FOV: 45 degrees.
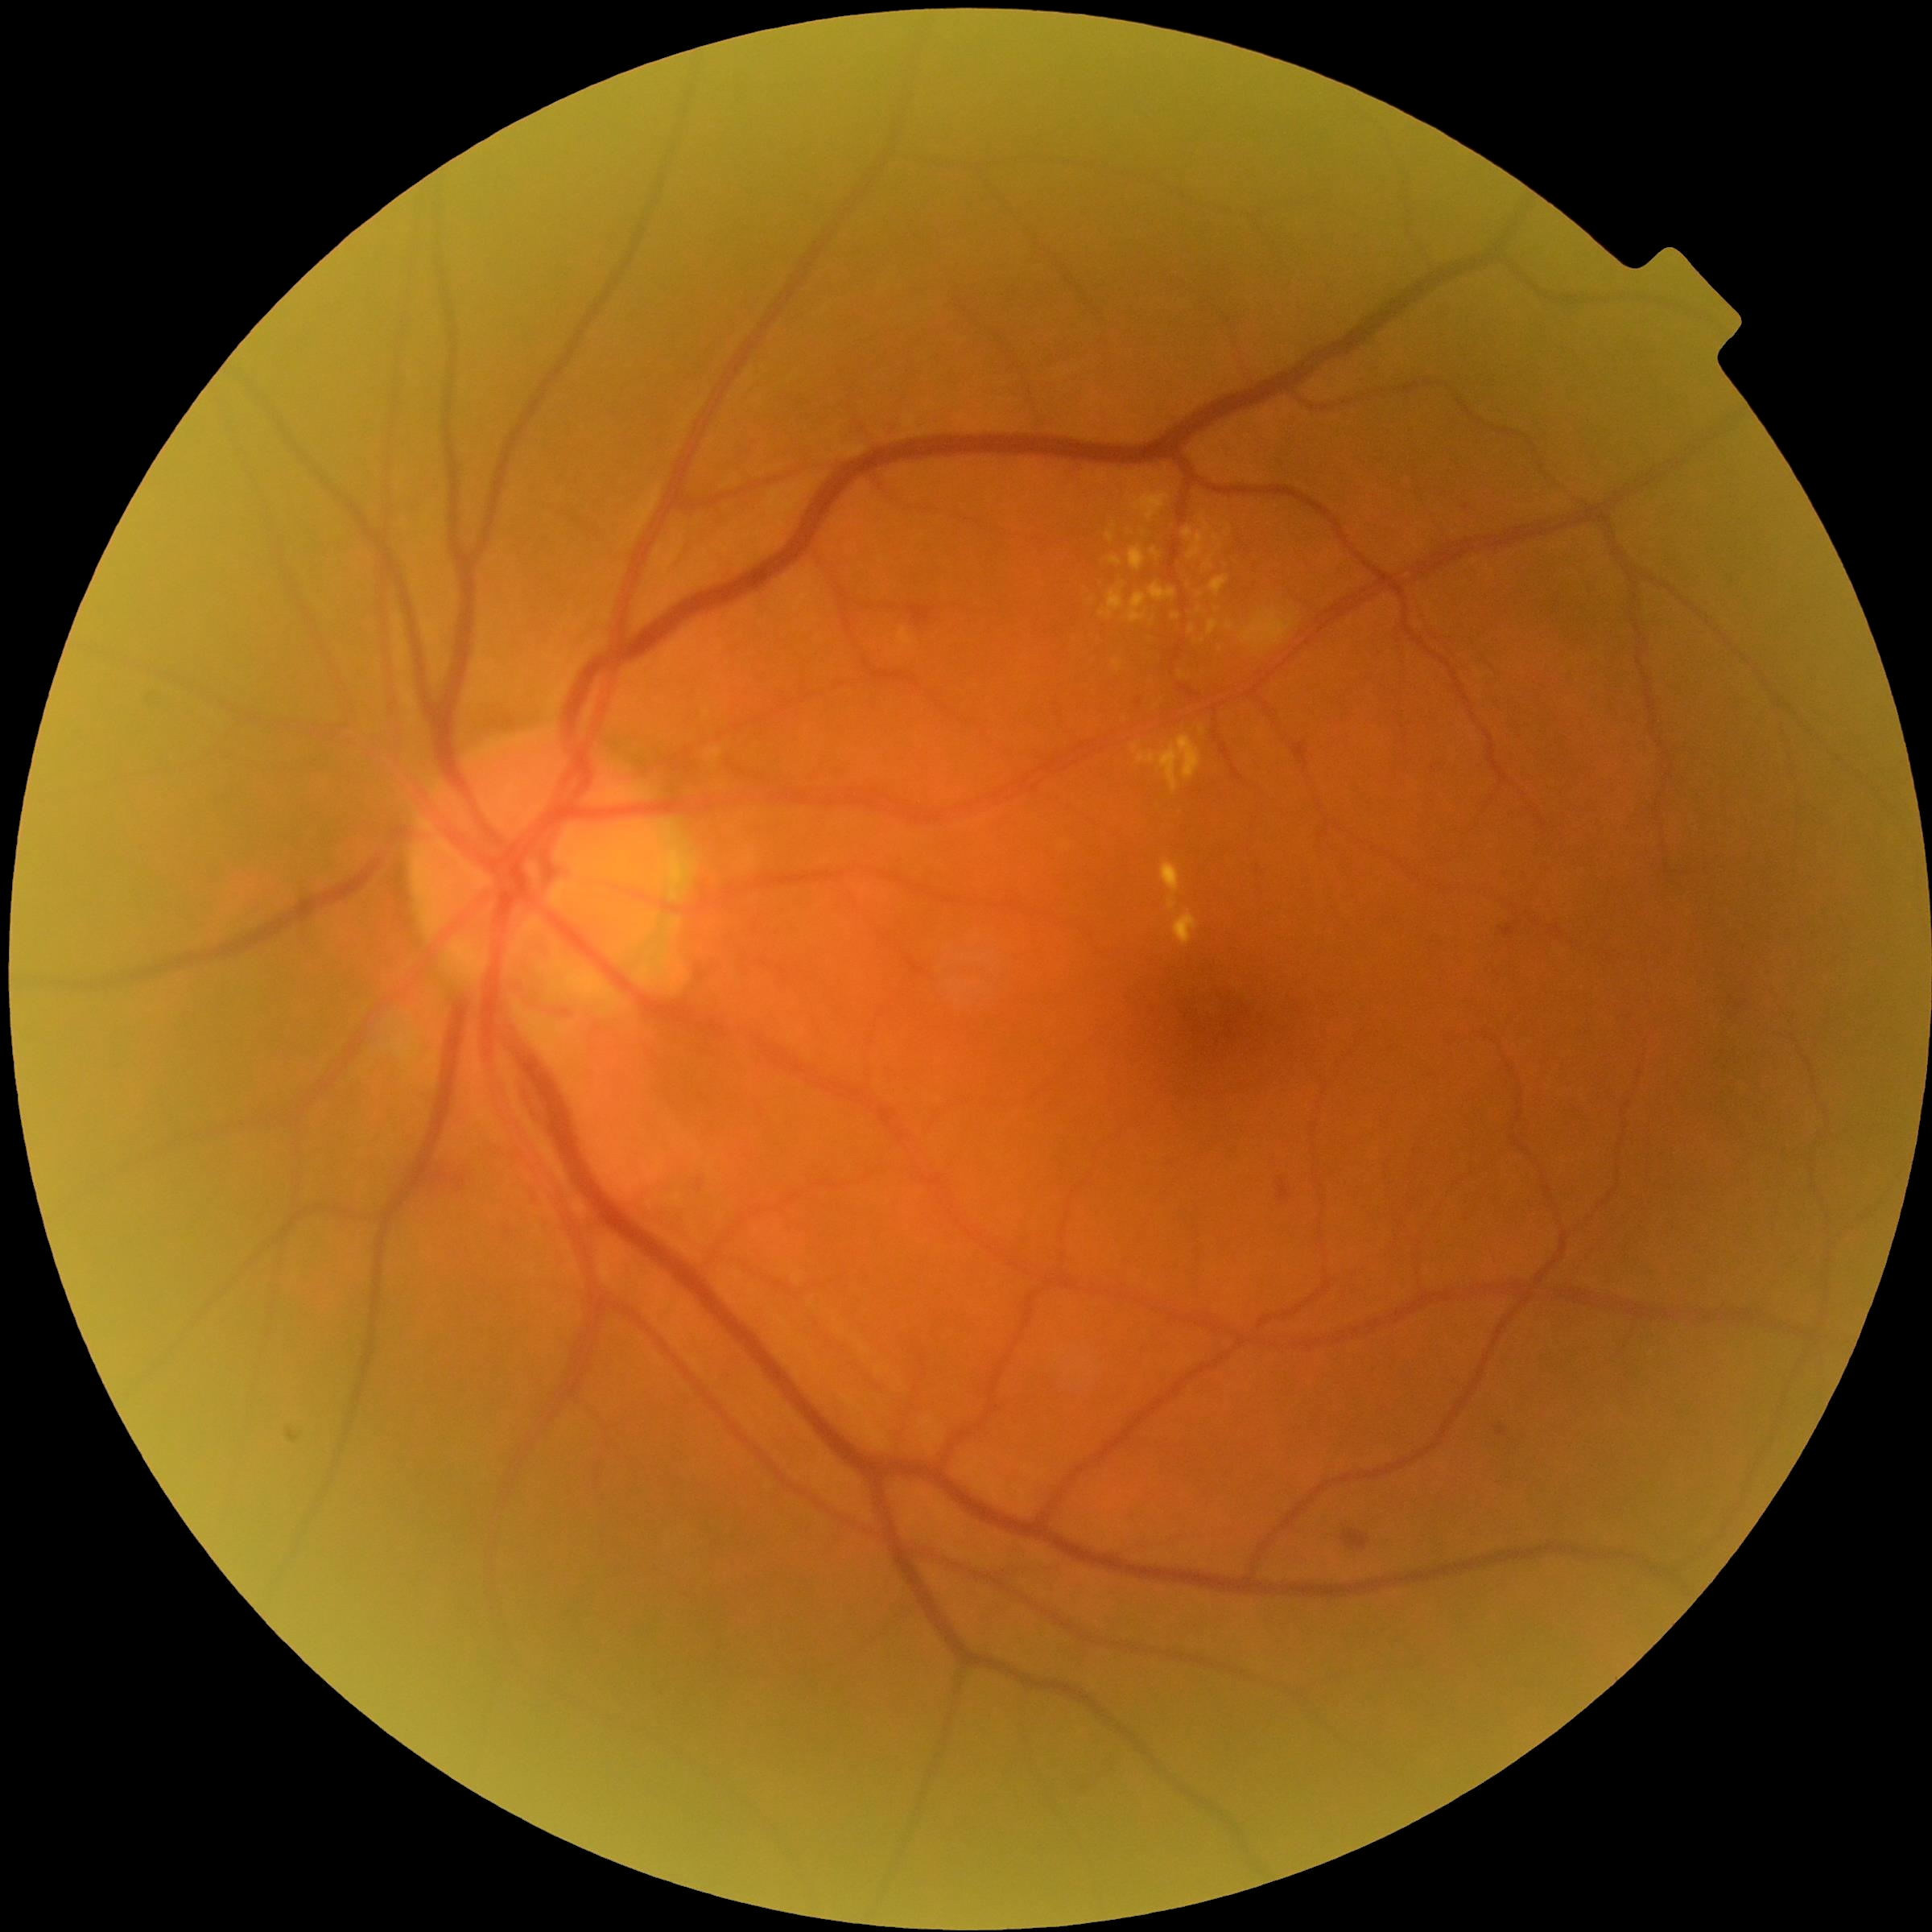

Diabetic retinopathy grade is 2. Hard exudates are present, including at box=[1151, 548, 1162, 559], box=[1100, 584, 1125, 619], box=[1127, 593, 1147, 625], box=[1212, 576, 1230, 595], box=[1110, 557, 1123, 567], box=[1130, 488, 1170, 522], box=[1129, 546, 1146, 572], box=[1113, 660, 1123, 674], box=[1226, 621, 1234, 630]. Small hard exudates approximately at pt(1144, 533), pt(1210, 565), pt(1193, 631), pt(1228, 532).